45° FOV.
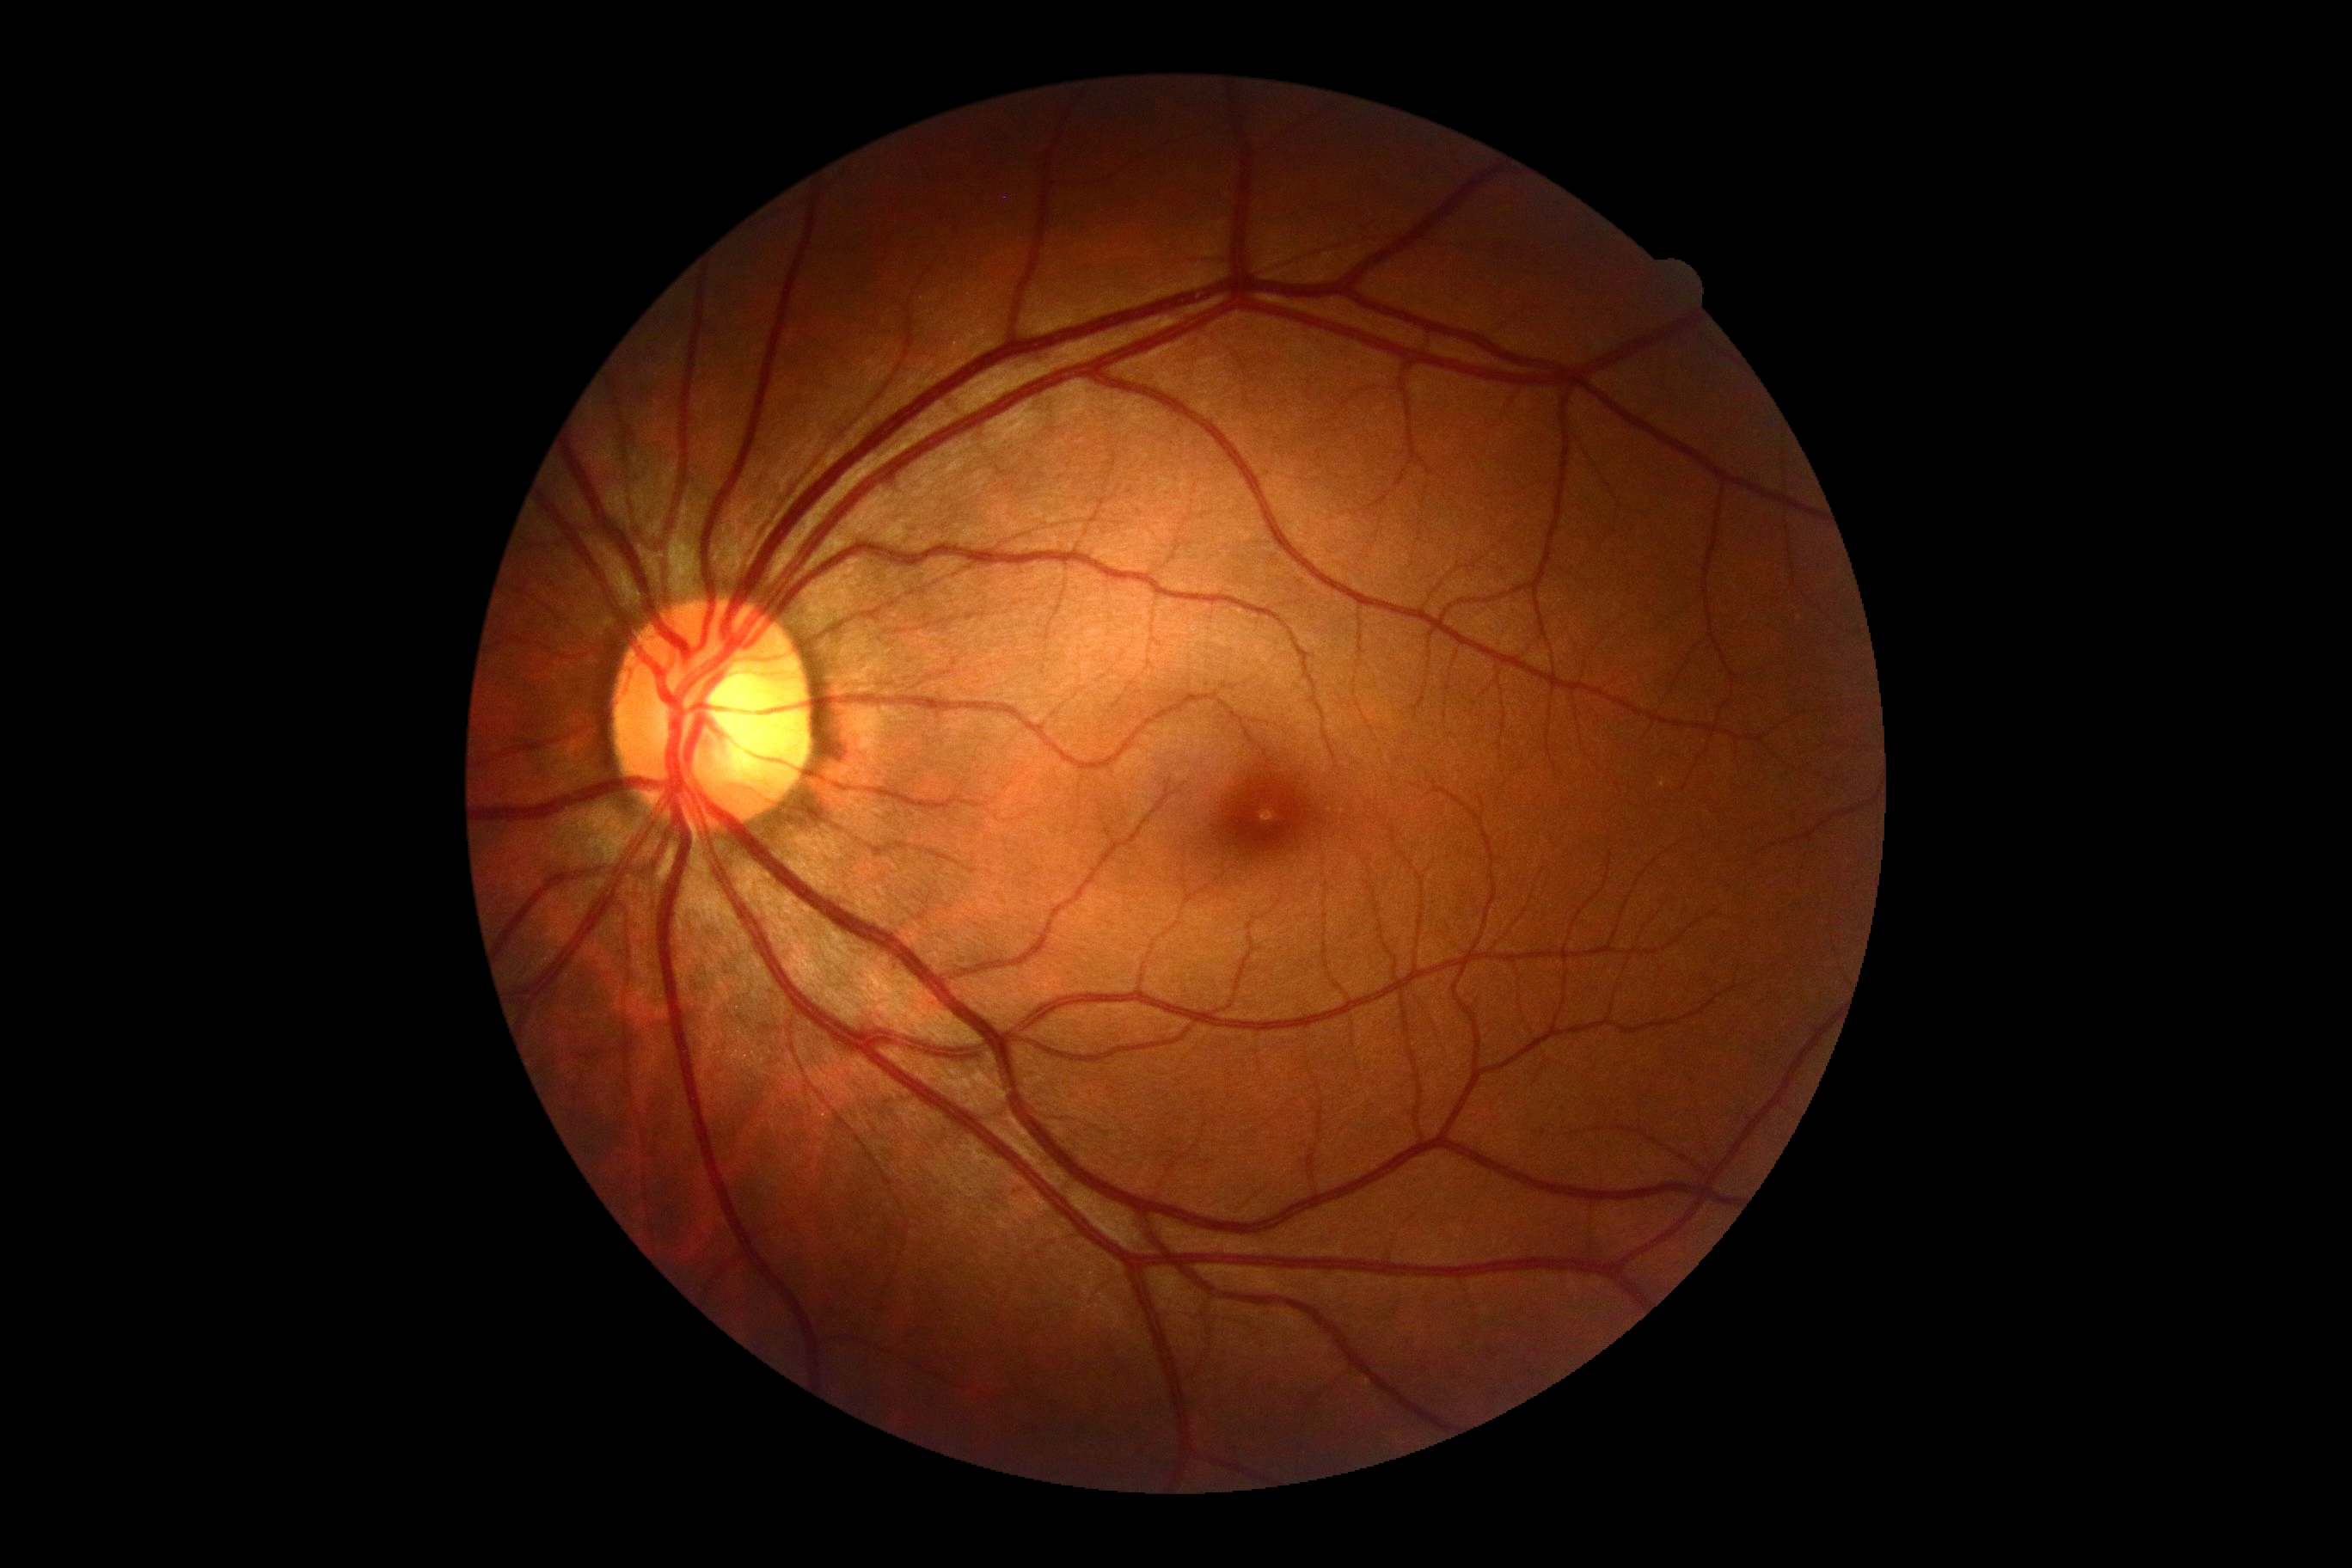
Retinopathy grade is 0.